Infant wide-field retinal image.
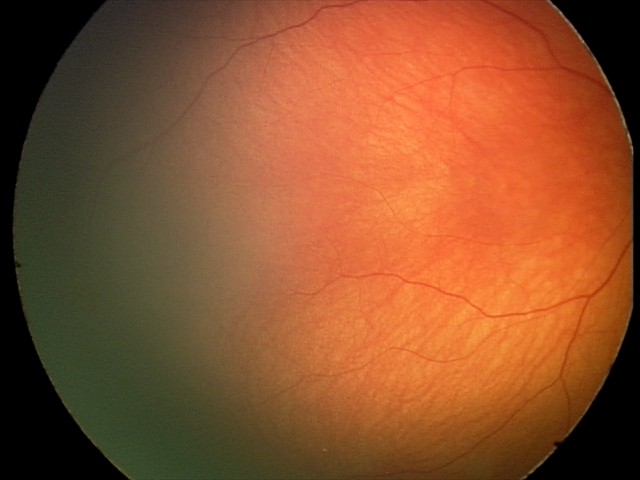 Screening examination with no abnormal retinal findings.